CFP: 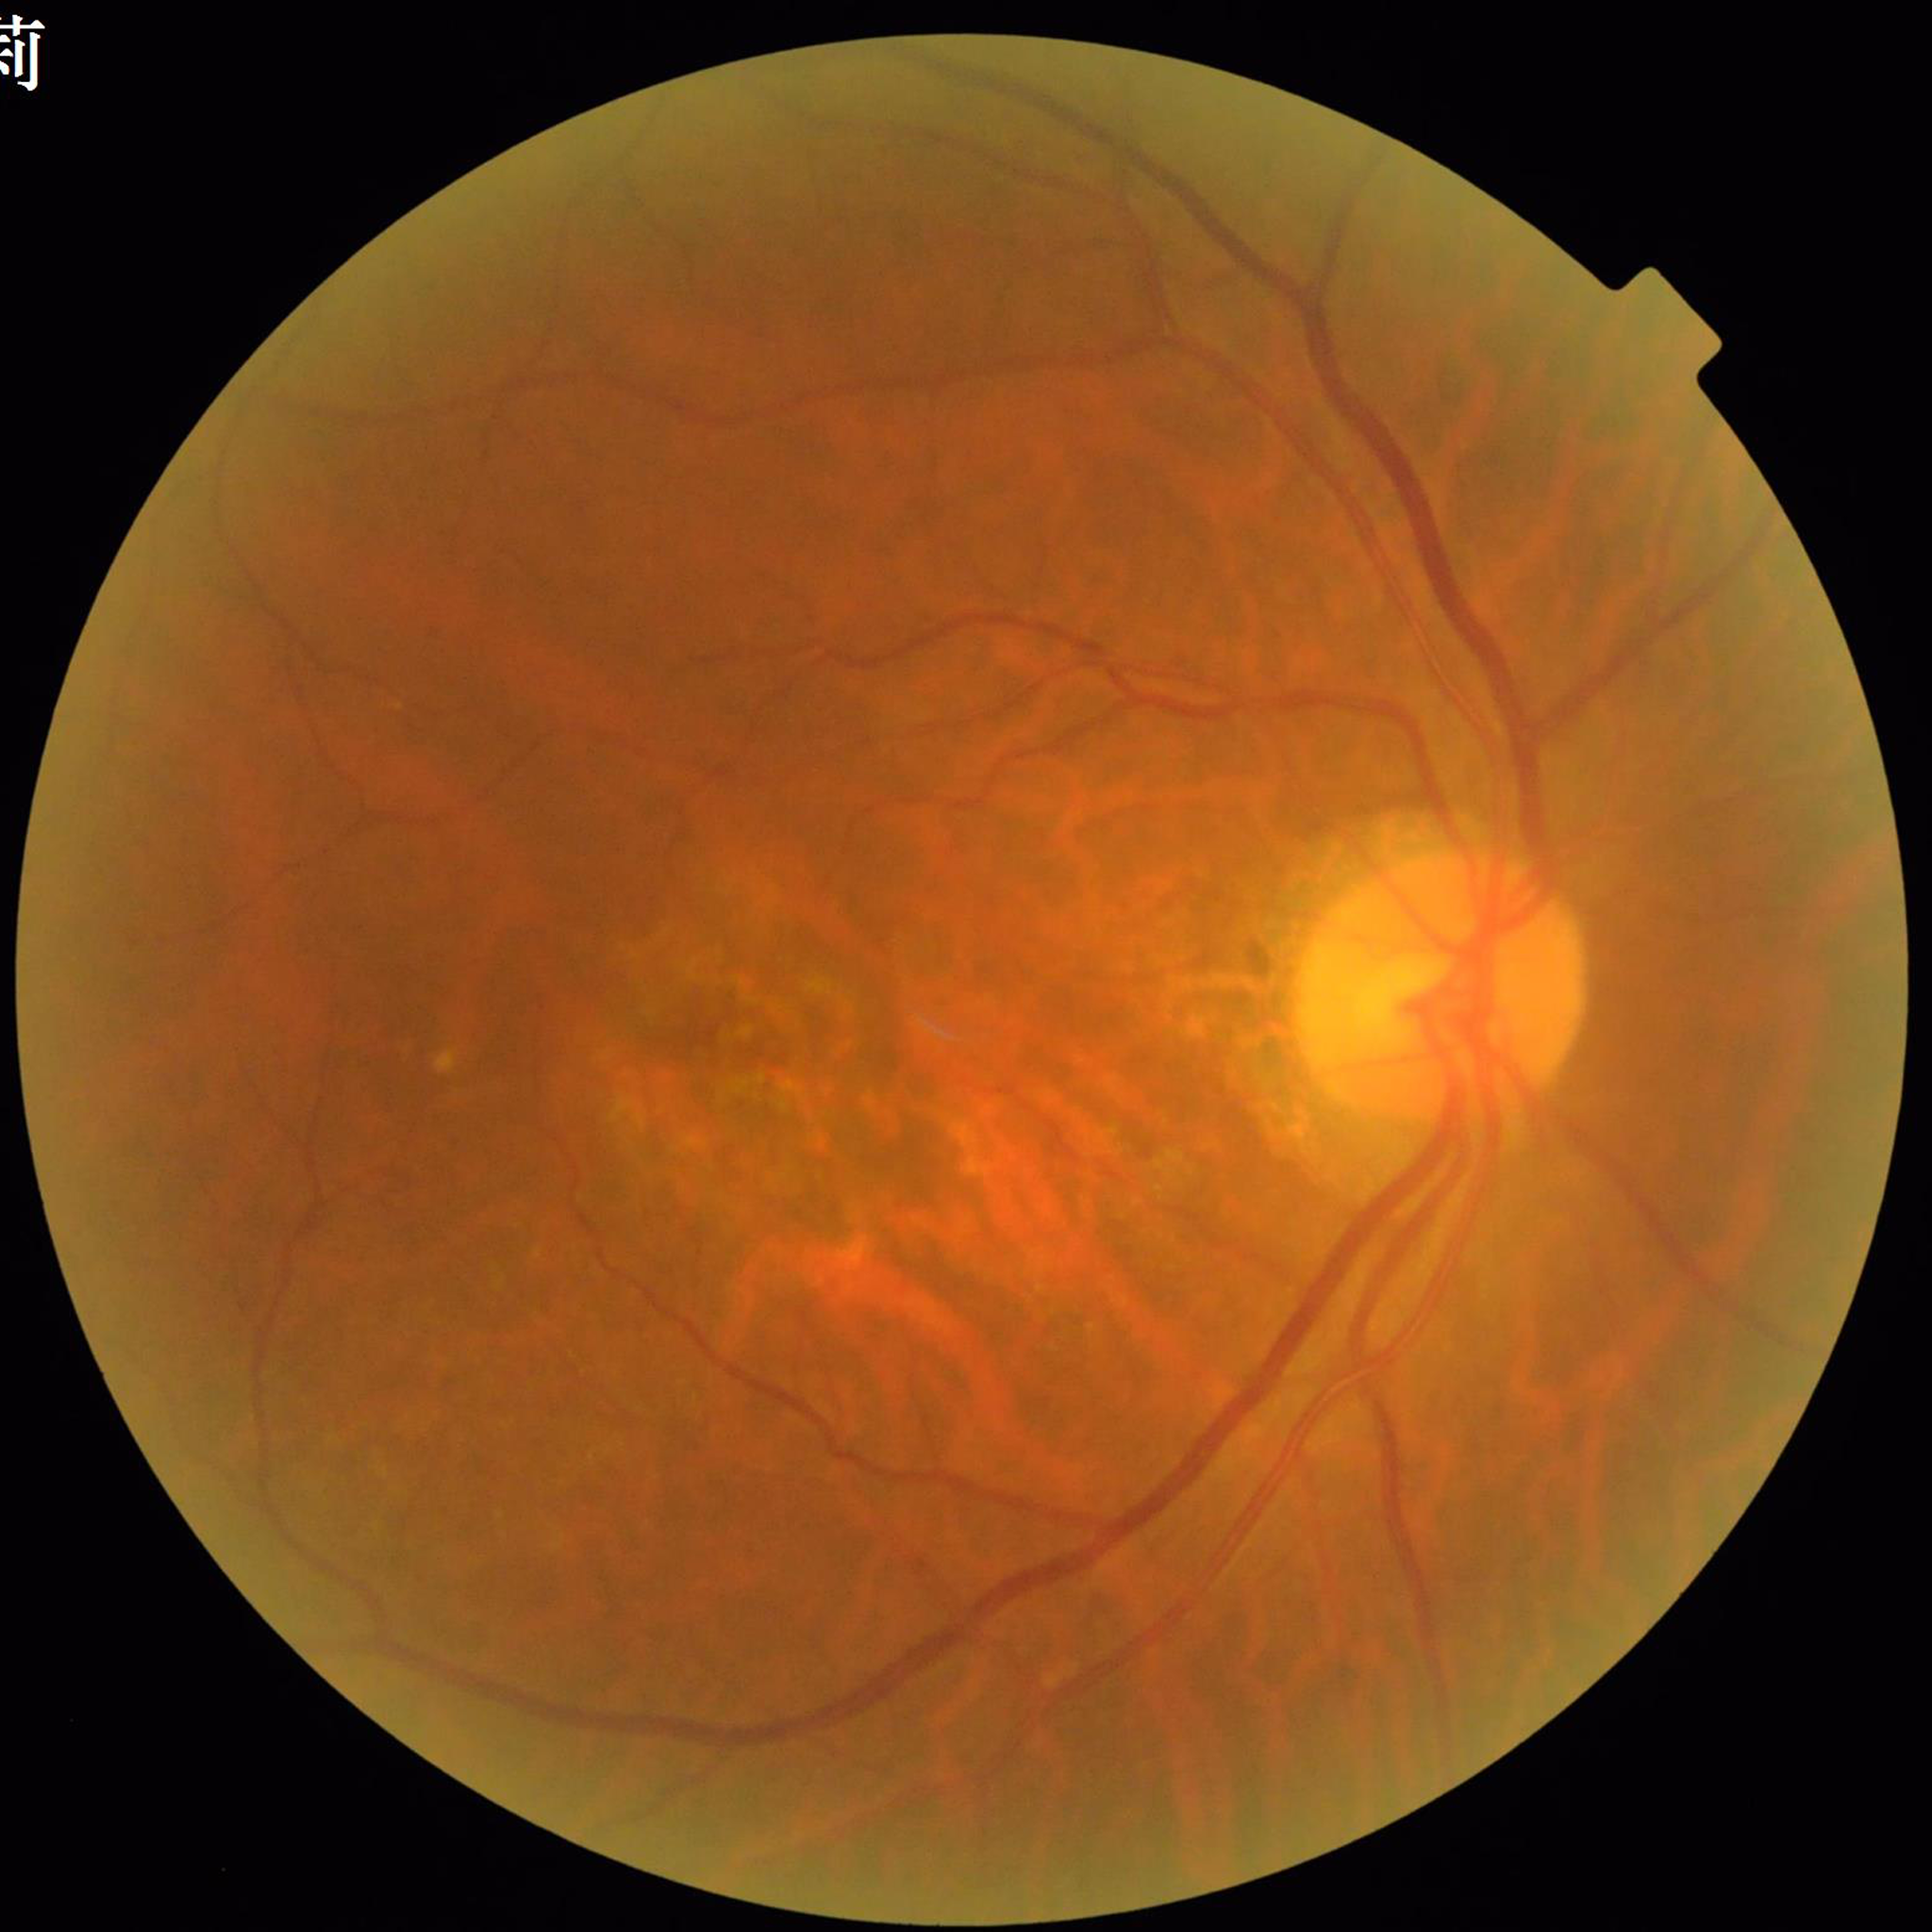

From a patient with age-related macular degeneration.